Diabetic retinopathy graded by the modified Davis classification; image size 848x848; 45° FOV; nonmydriatic; acquired with a NIDEK AFC-230:
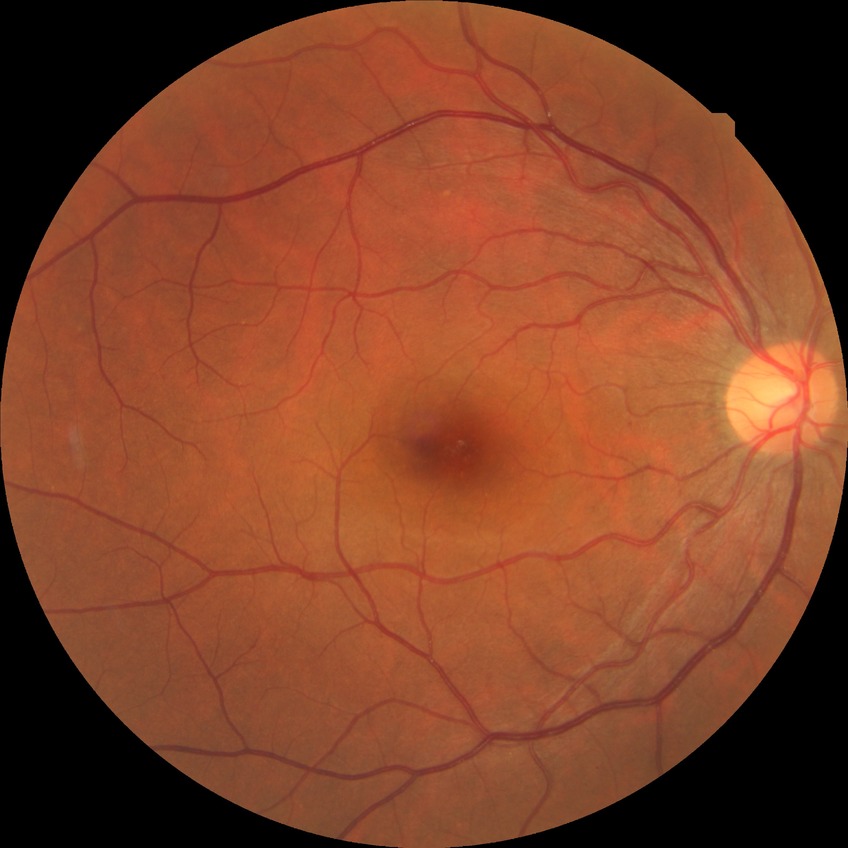

dr_impression: no apparent DR
davis_grade: NDR